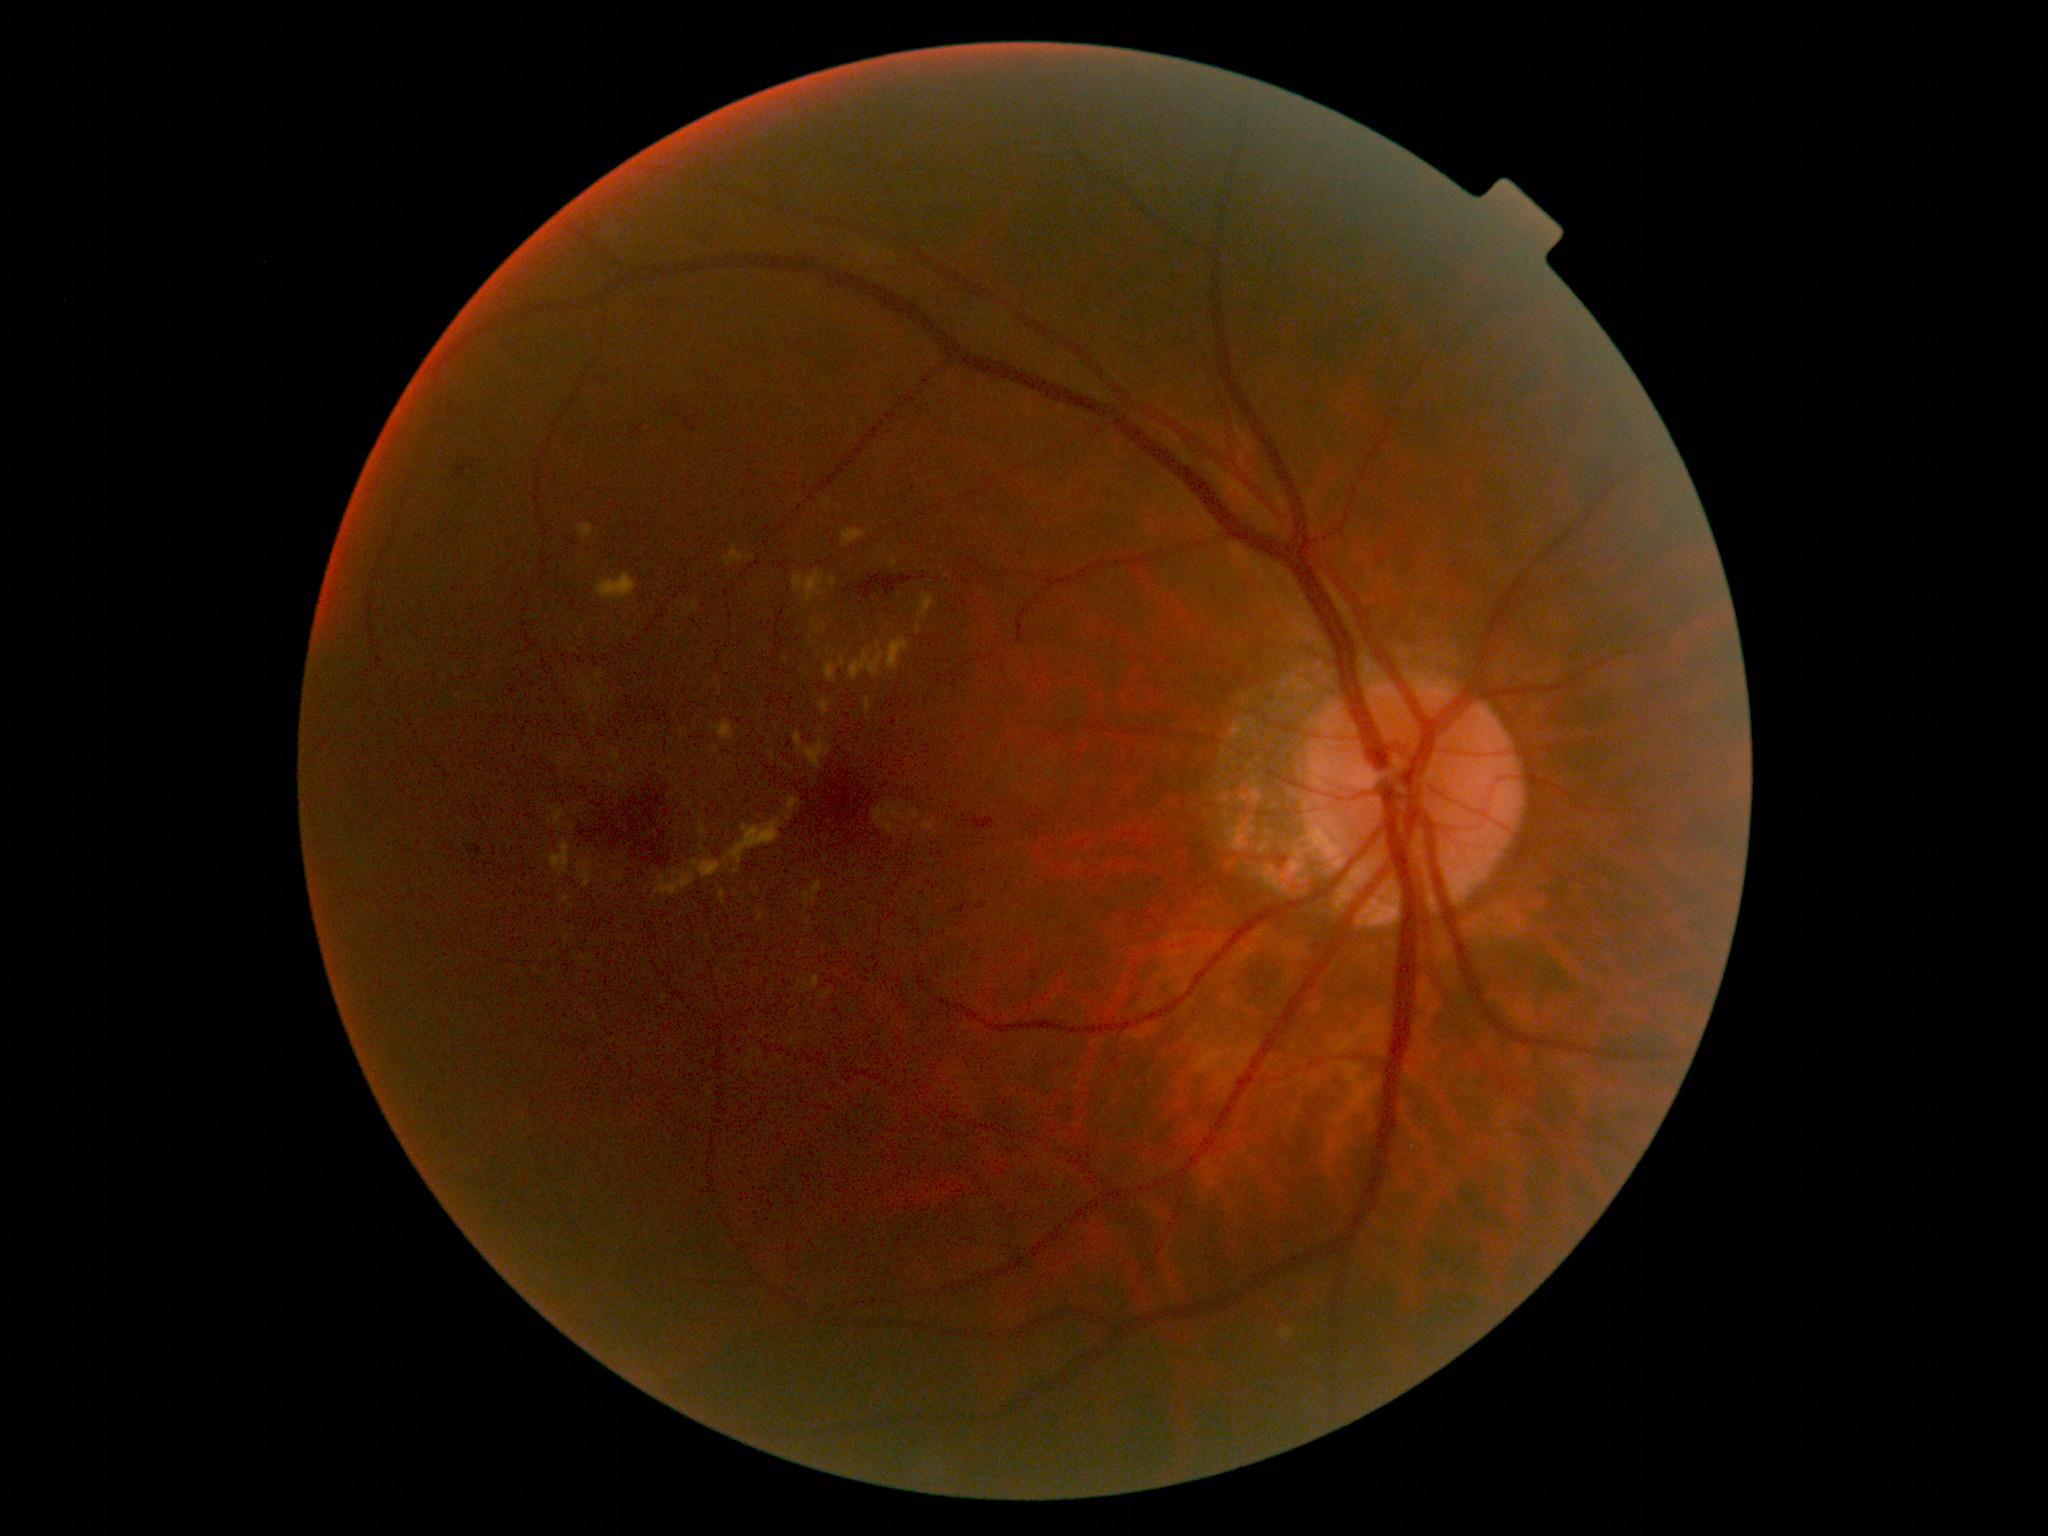

Findings:
– diabetic retinopathy (DR) — 2